Wide-field contact fundus photograph of an infant
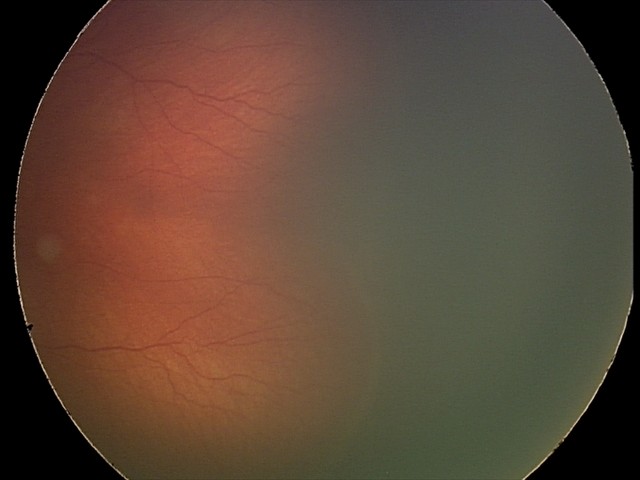
Screening series with retinopathy of prematurity (ROP) stage 2.